Optic disc-centered crop — 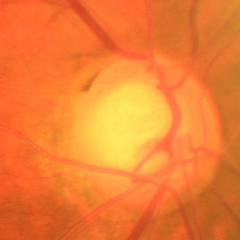 Glaucoma status: early glaucomatous optic neuropathy.